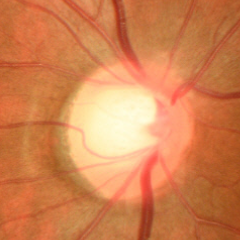
Fundus appearance consistent with early glaucomatous optic neuropathy. Defined as glaucomatous retinal nerve fiber layer defects on red-free fundus photography without visual field defects.